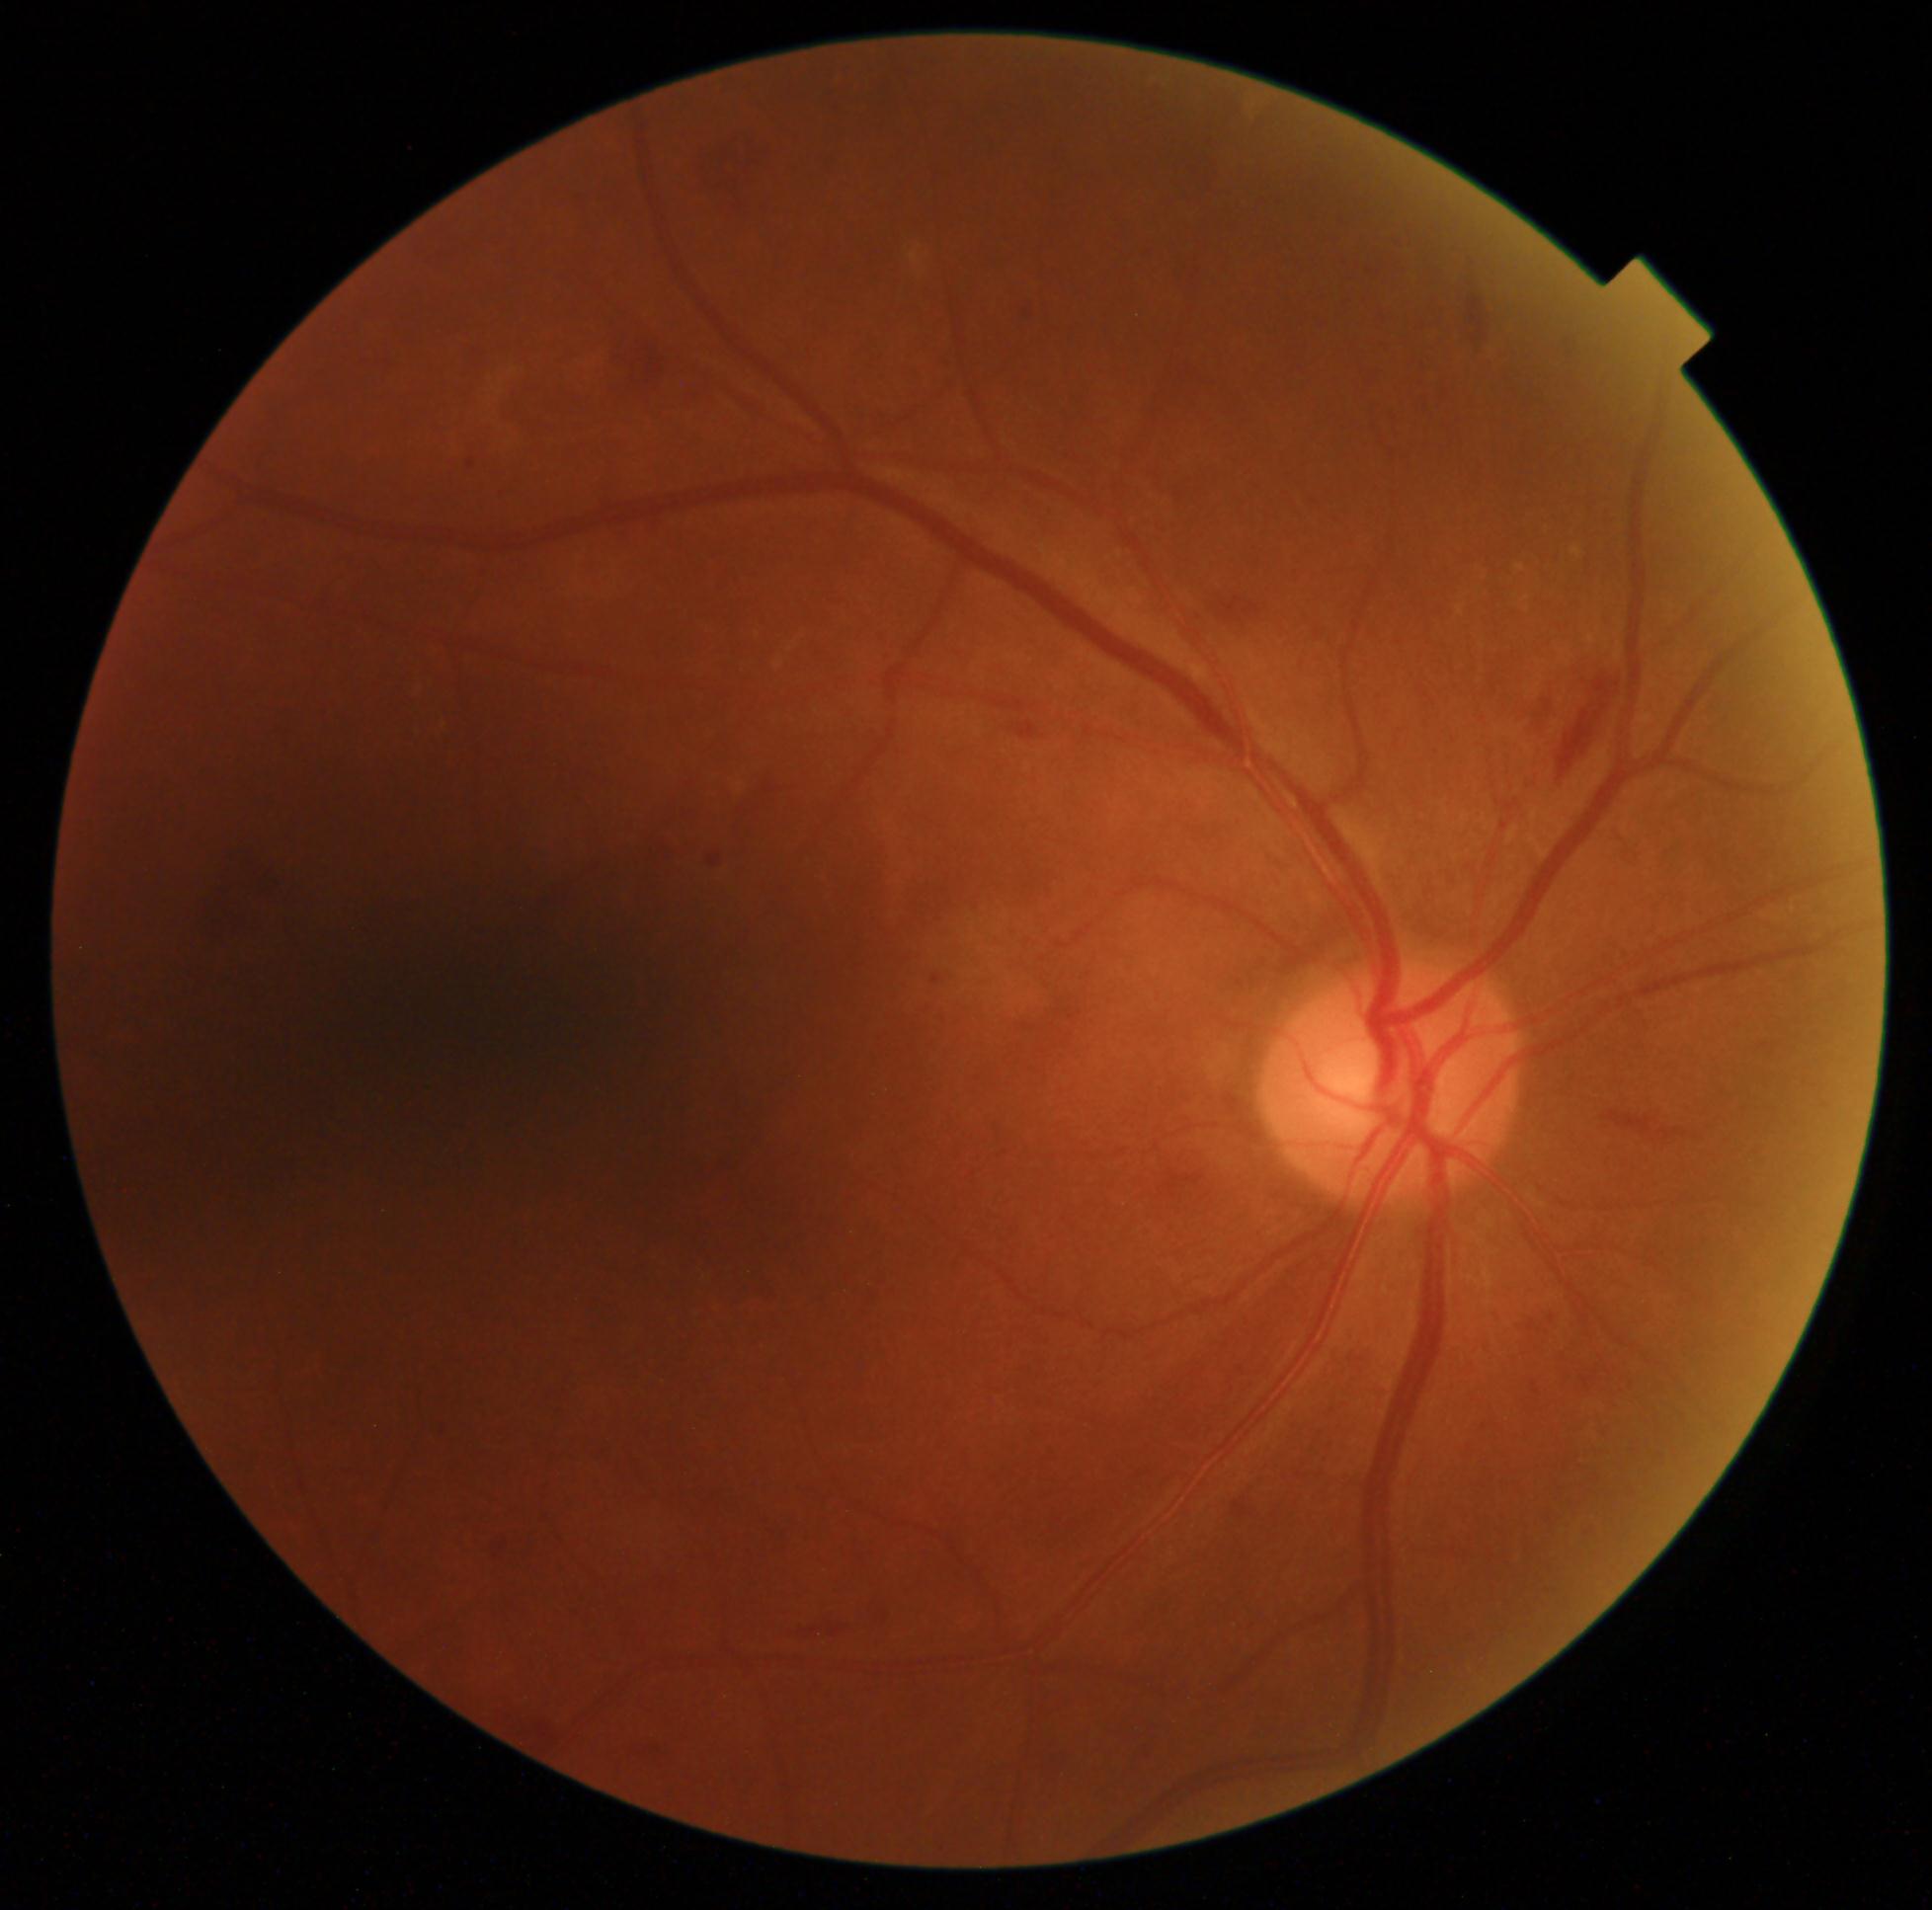

  dr_grade: 2 (moderate NPDR) — more than just microaneurysms but less than severe NPDR